Fundus photo; 45° FOV — 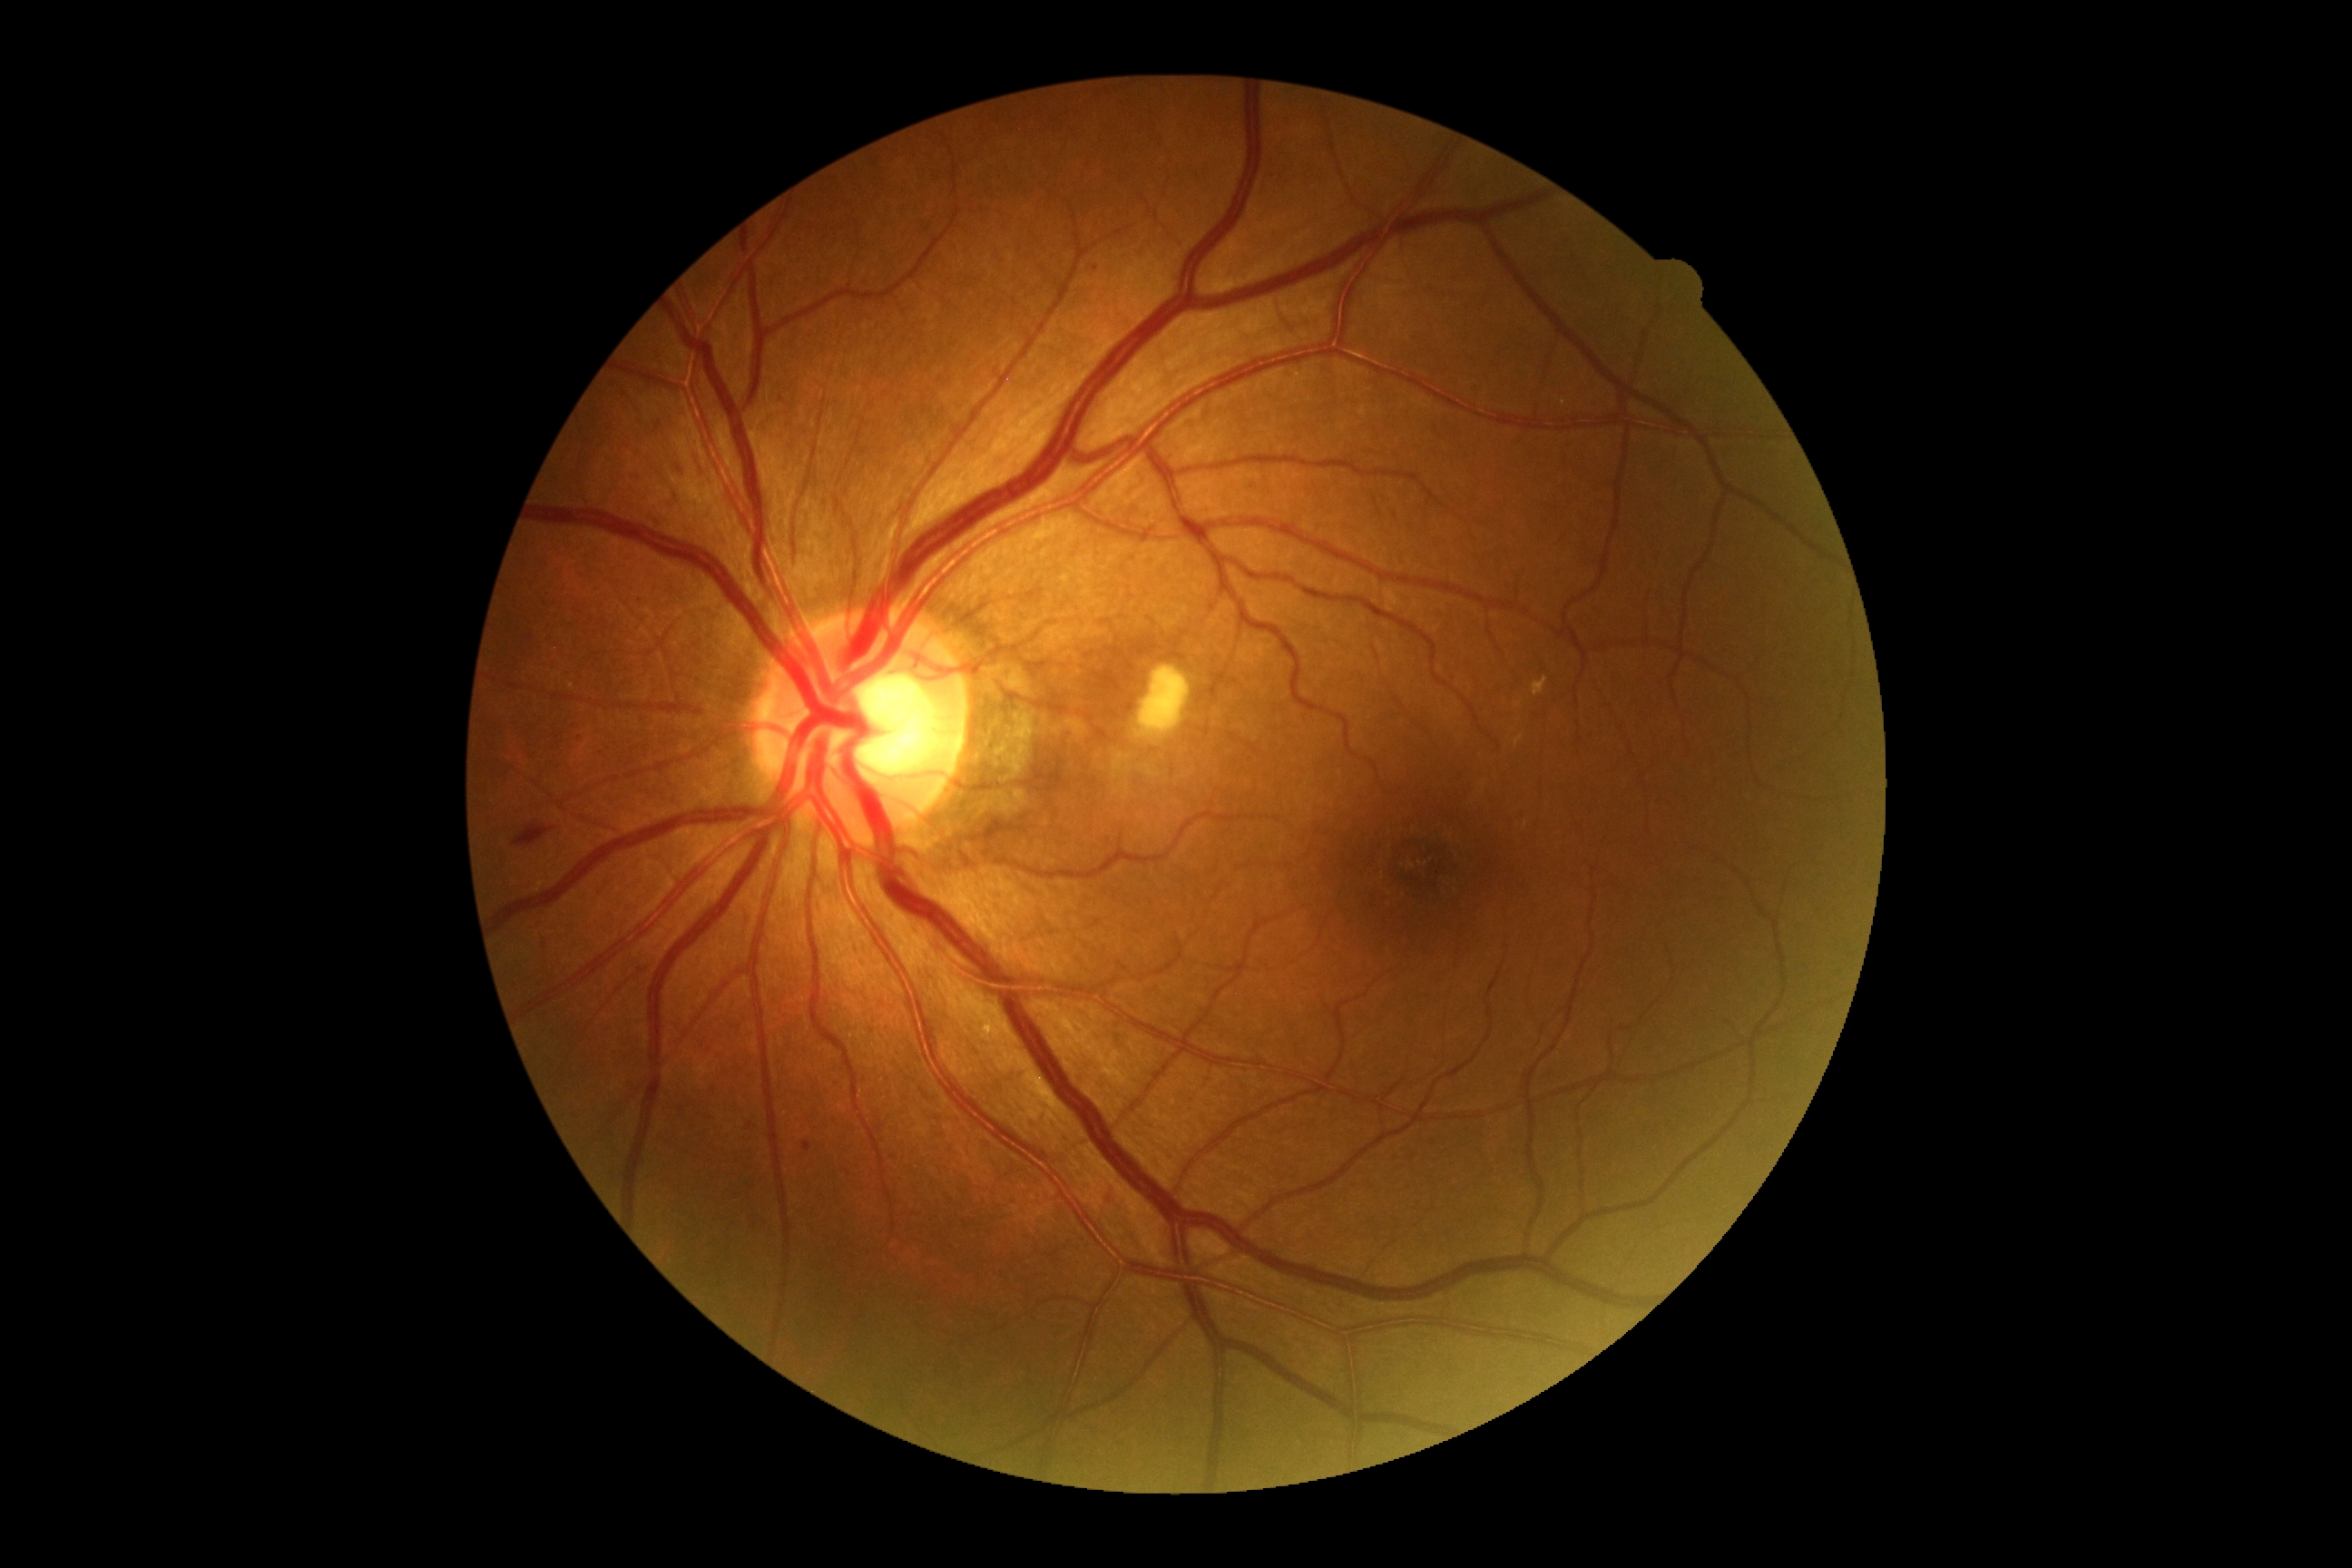
DR grade is 2 (moderate NPDR).